Modified Davis classification, no pharmacologic dilation, 45° FOV:
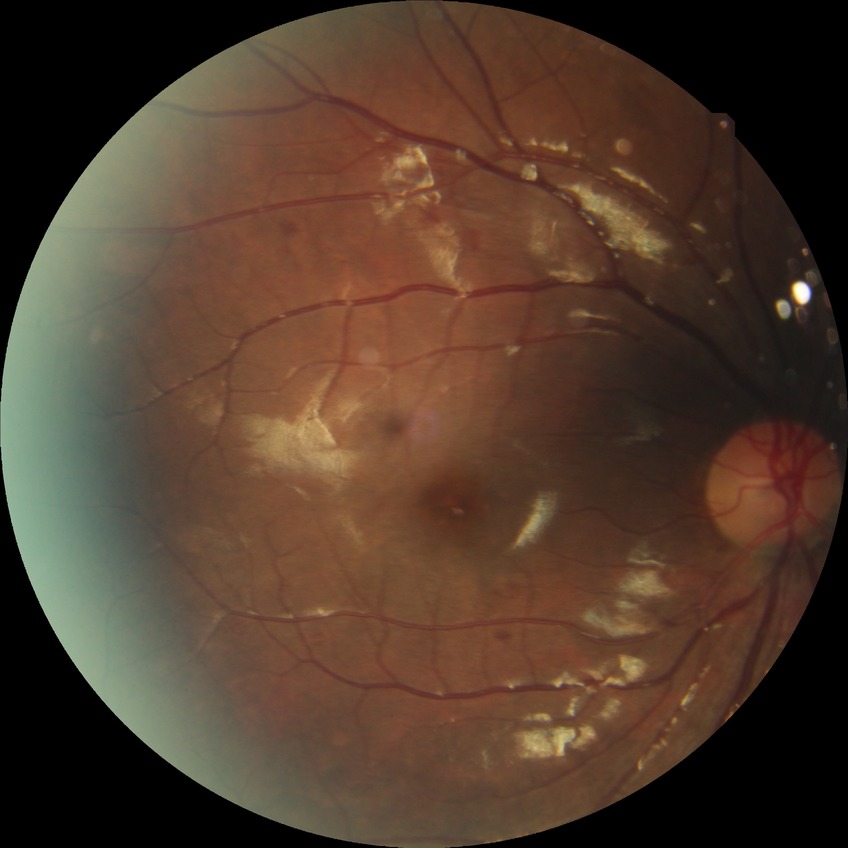

Diabetic retinopathy severity: no diabetic retinopathy.